Nonmydriatic. 848x848. NIDEK AFC-230 fundus camera:
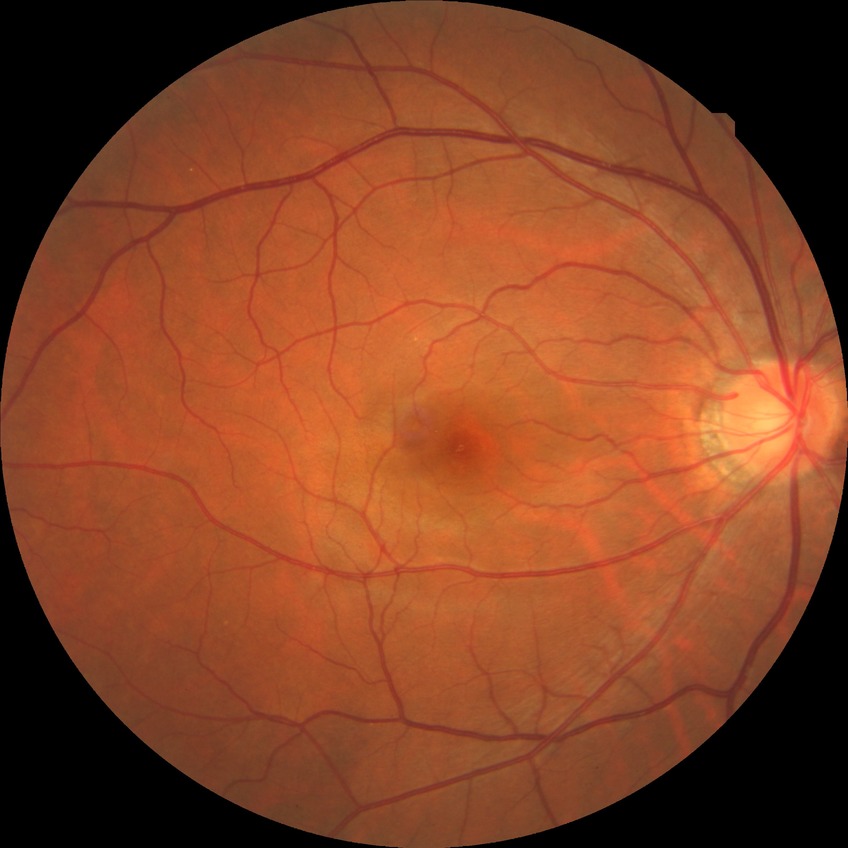

Annotations:
– diabetic retinopathy (DR) — NDR (no diabetic retinopathy)